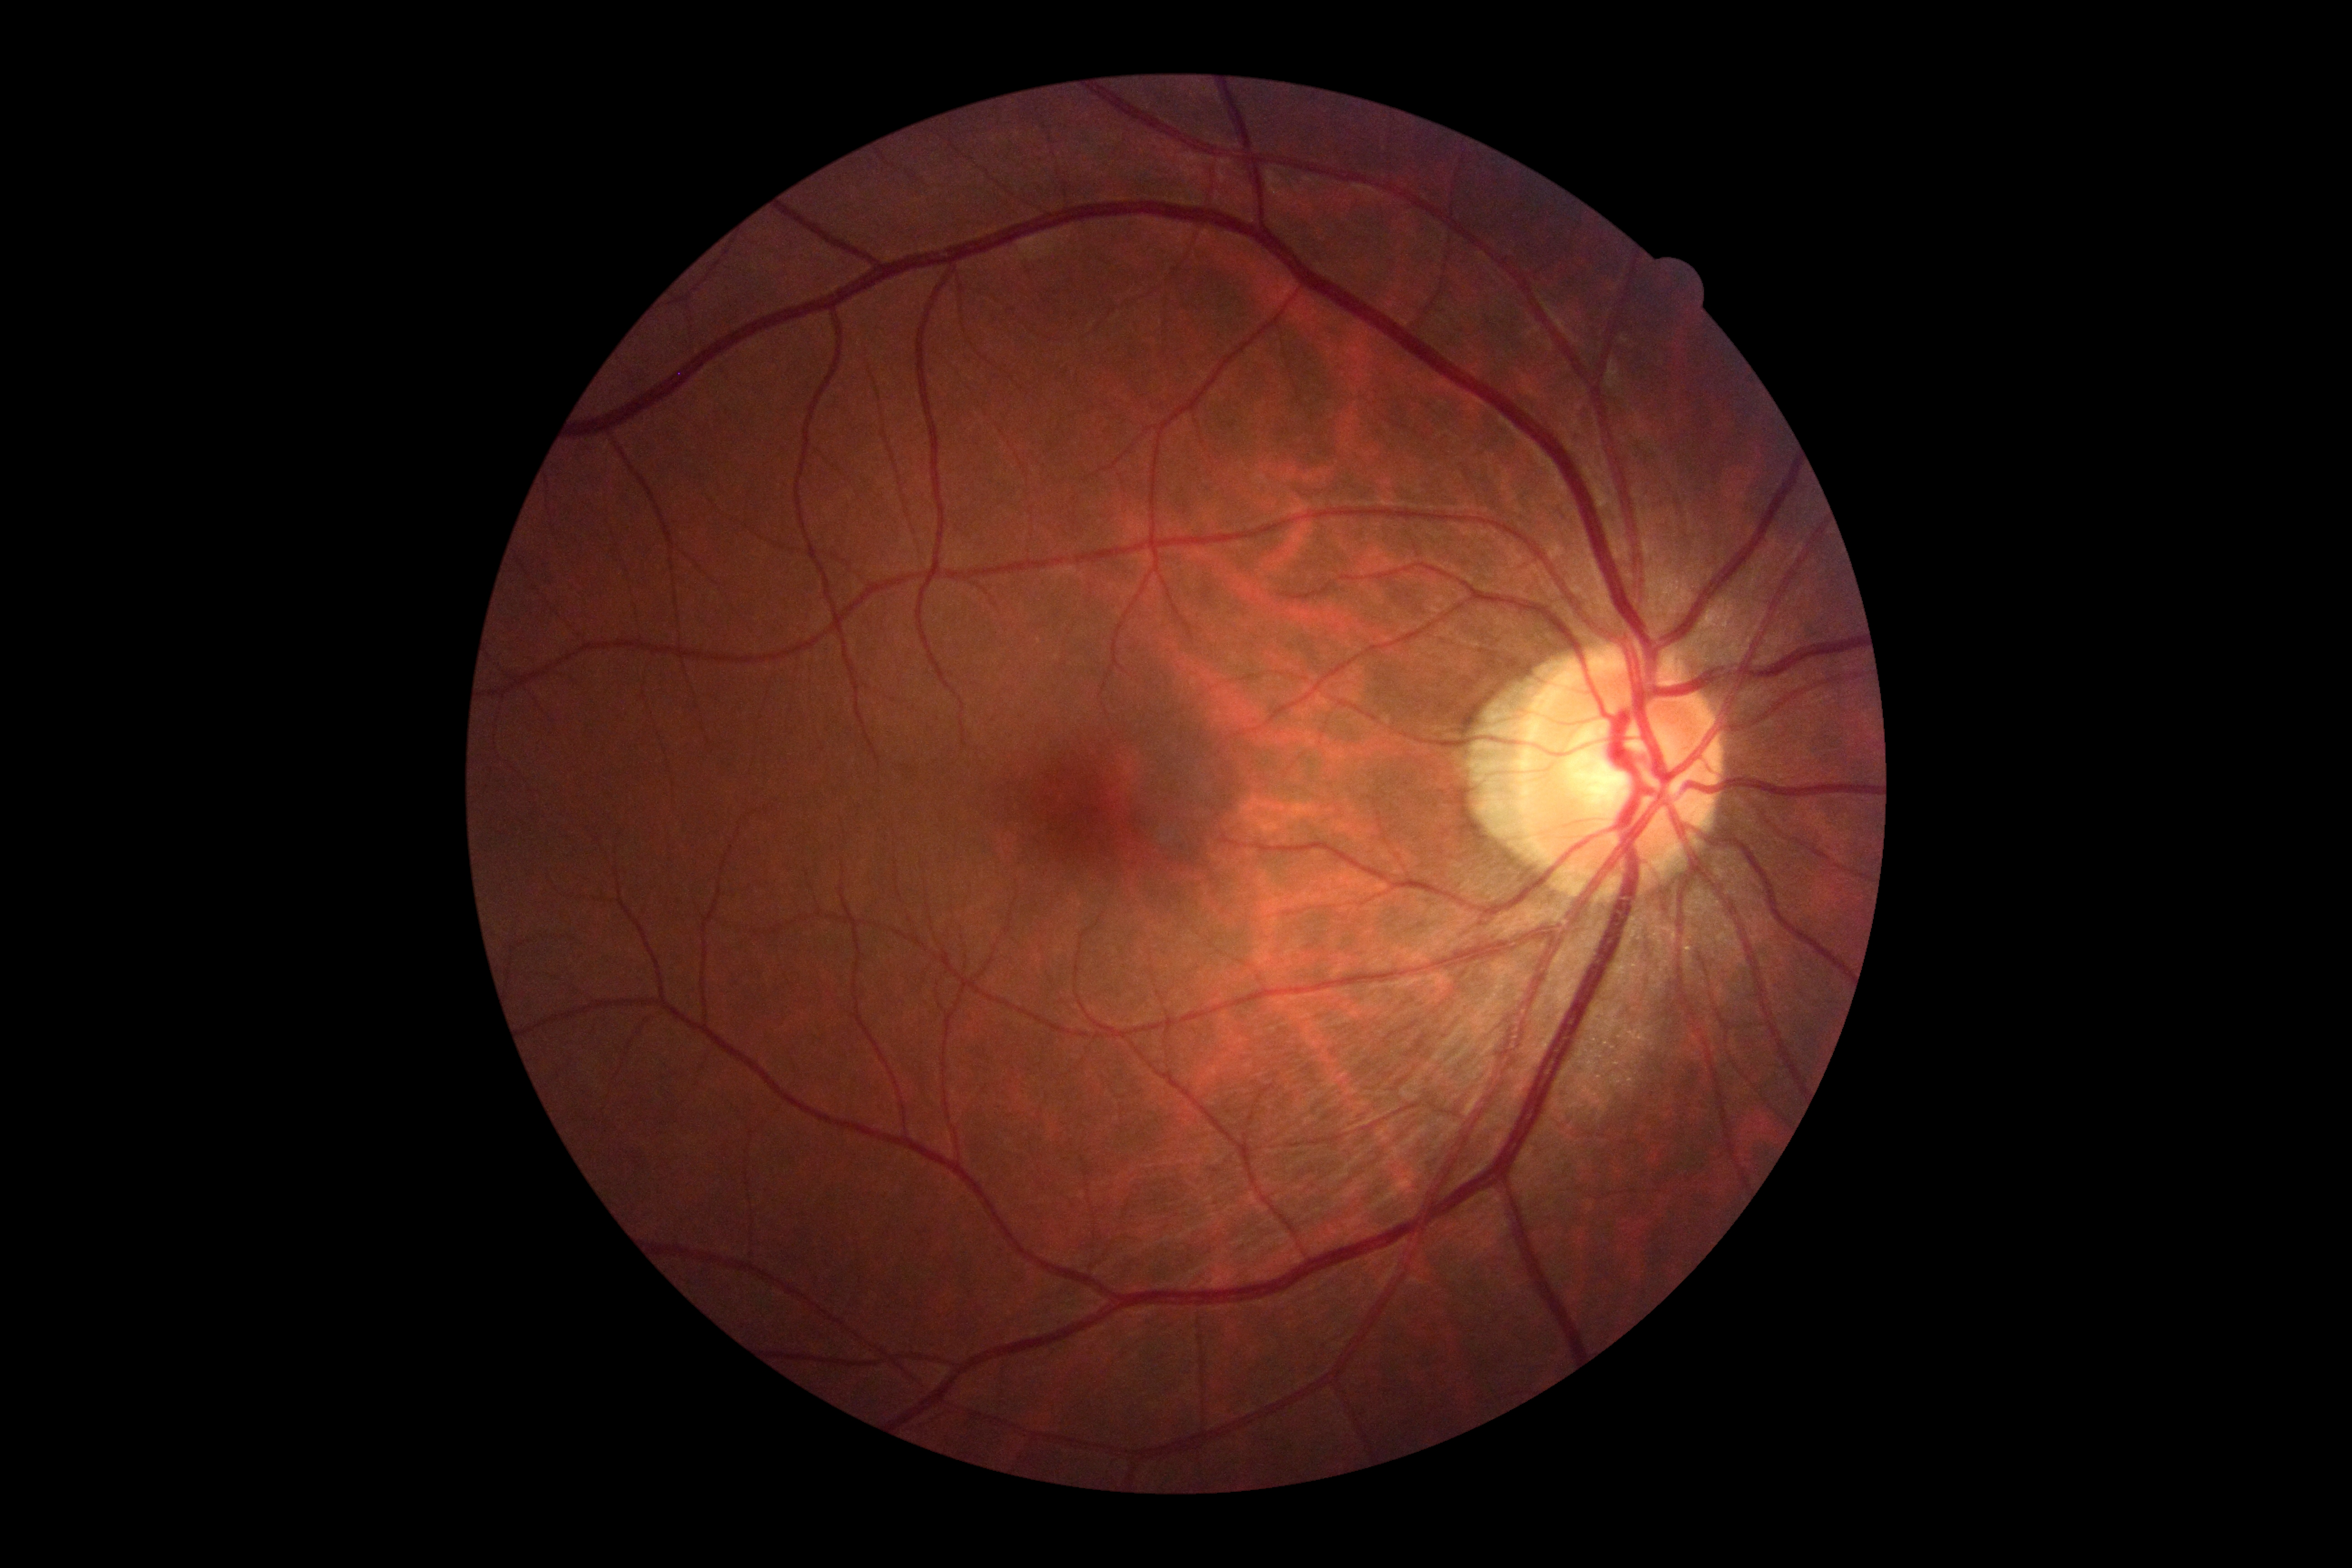 DR impression: no signs of DR; DR stage: no apparent retinopathy (grade 0).